Nonmydriatic, 848 by 848 pixels:
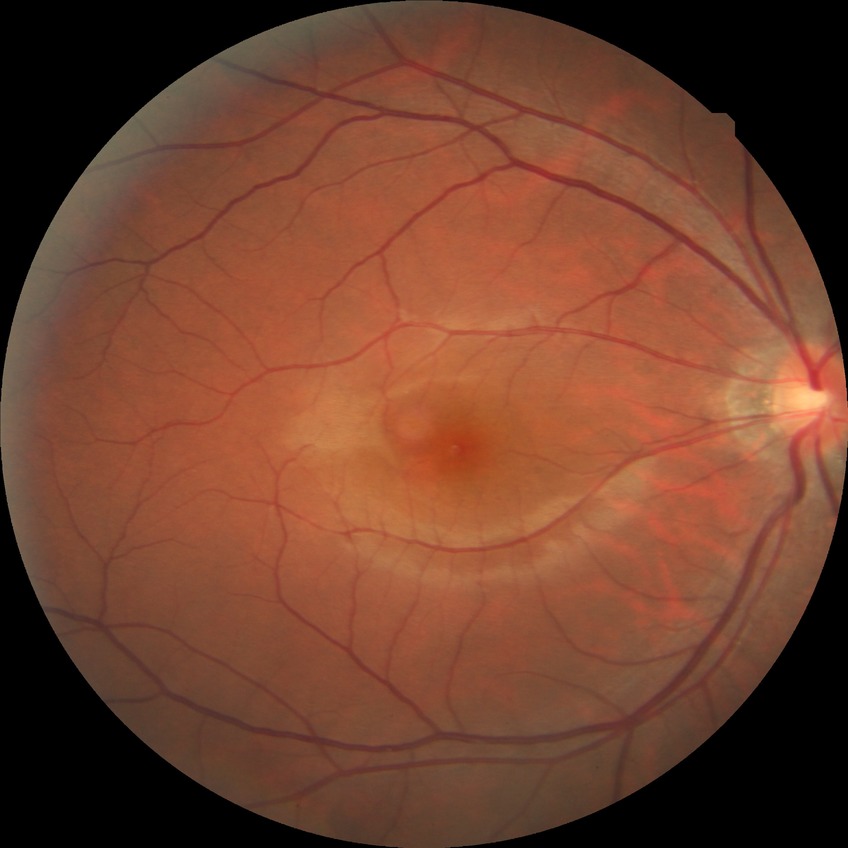 Diabetic retinopathy (DR): NDR (no diabetic retinopathy).